Undilated pupil; fundus photo: 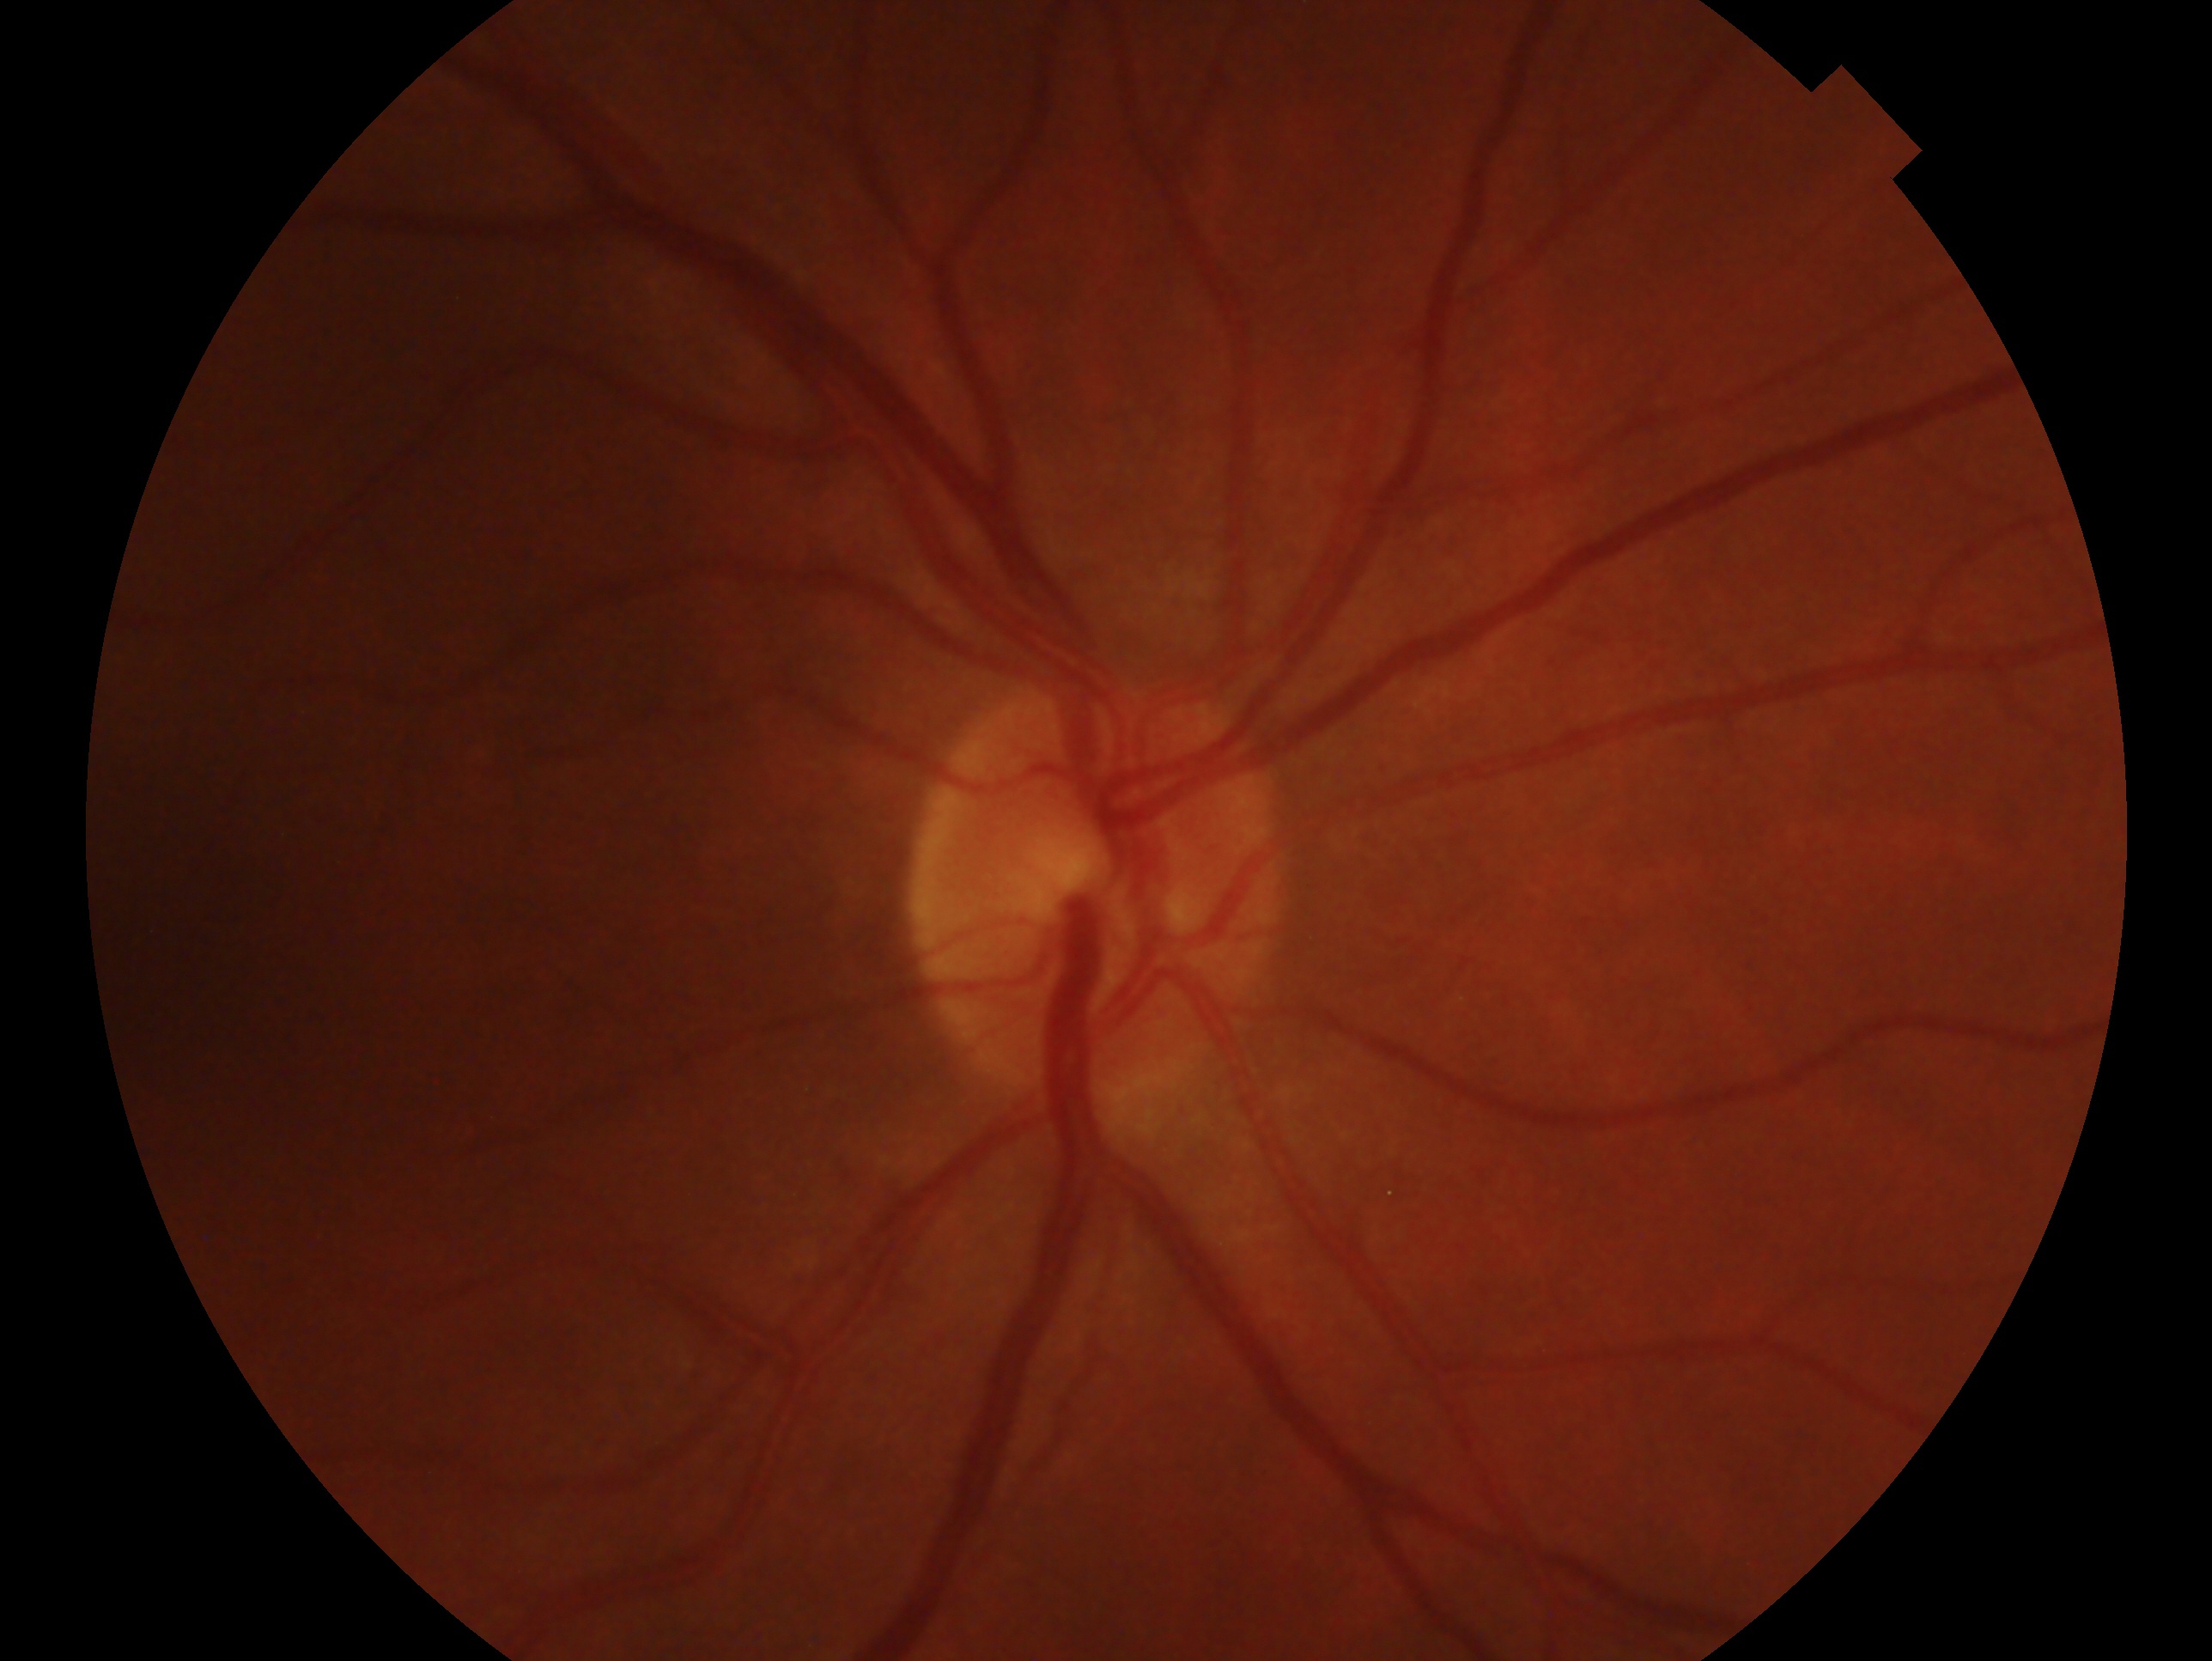
Impression: no glaucoma. Eye: right.